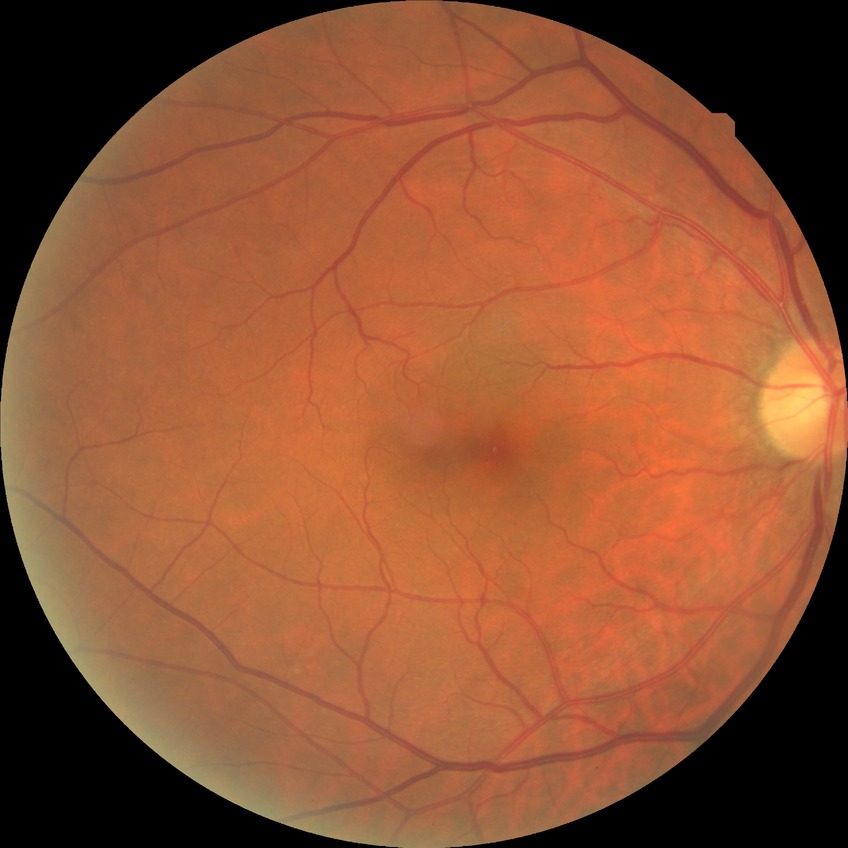 Assessment:
– Davis grading: no diabetic retinopathy